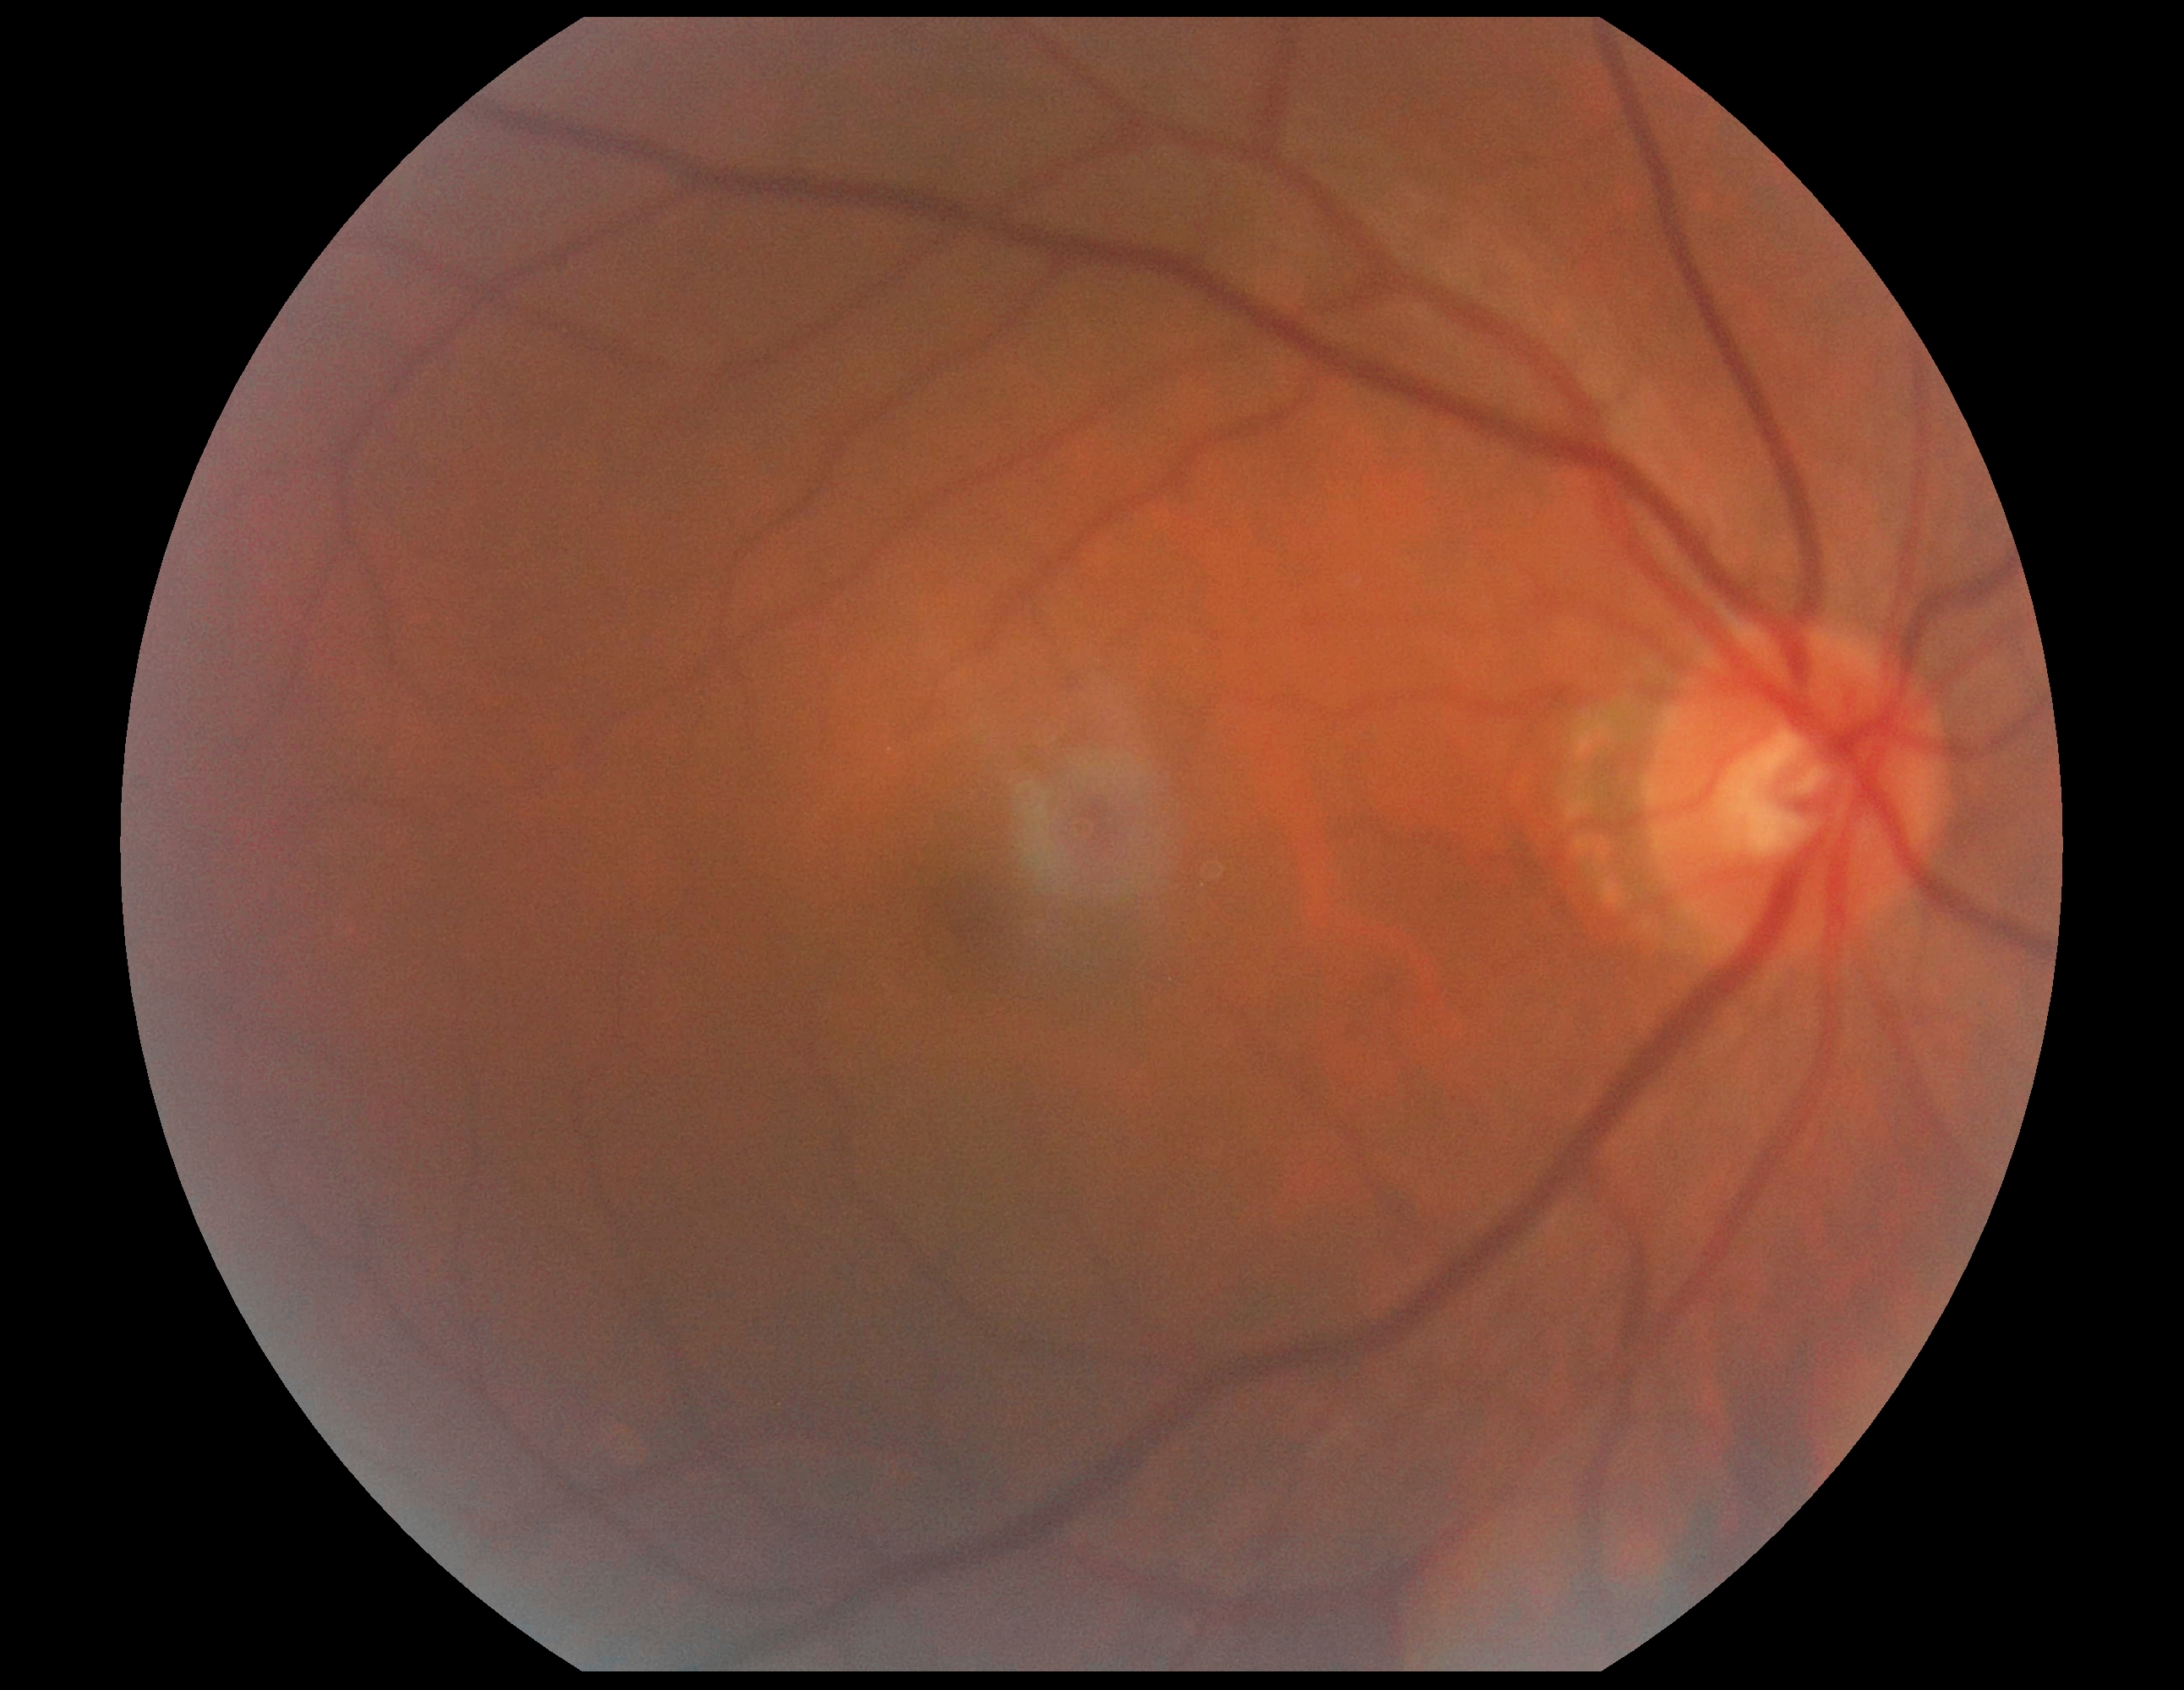

DR grade: 0 (no apparent retinopathy).
No diabetic retinal disease findings.